Fundus photo
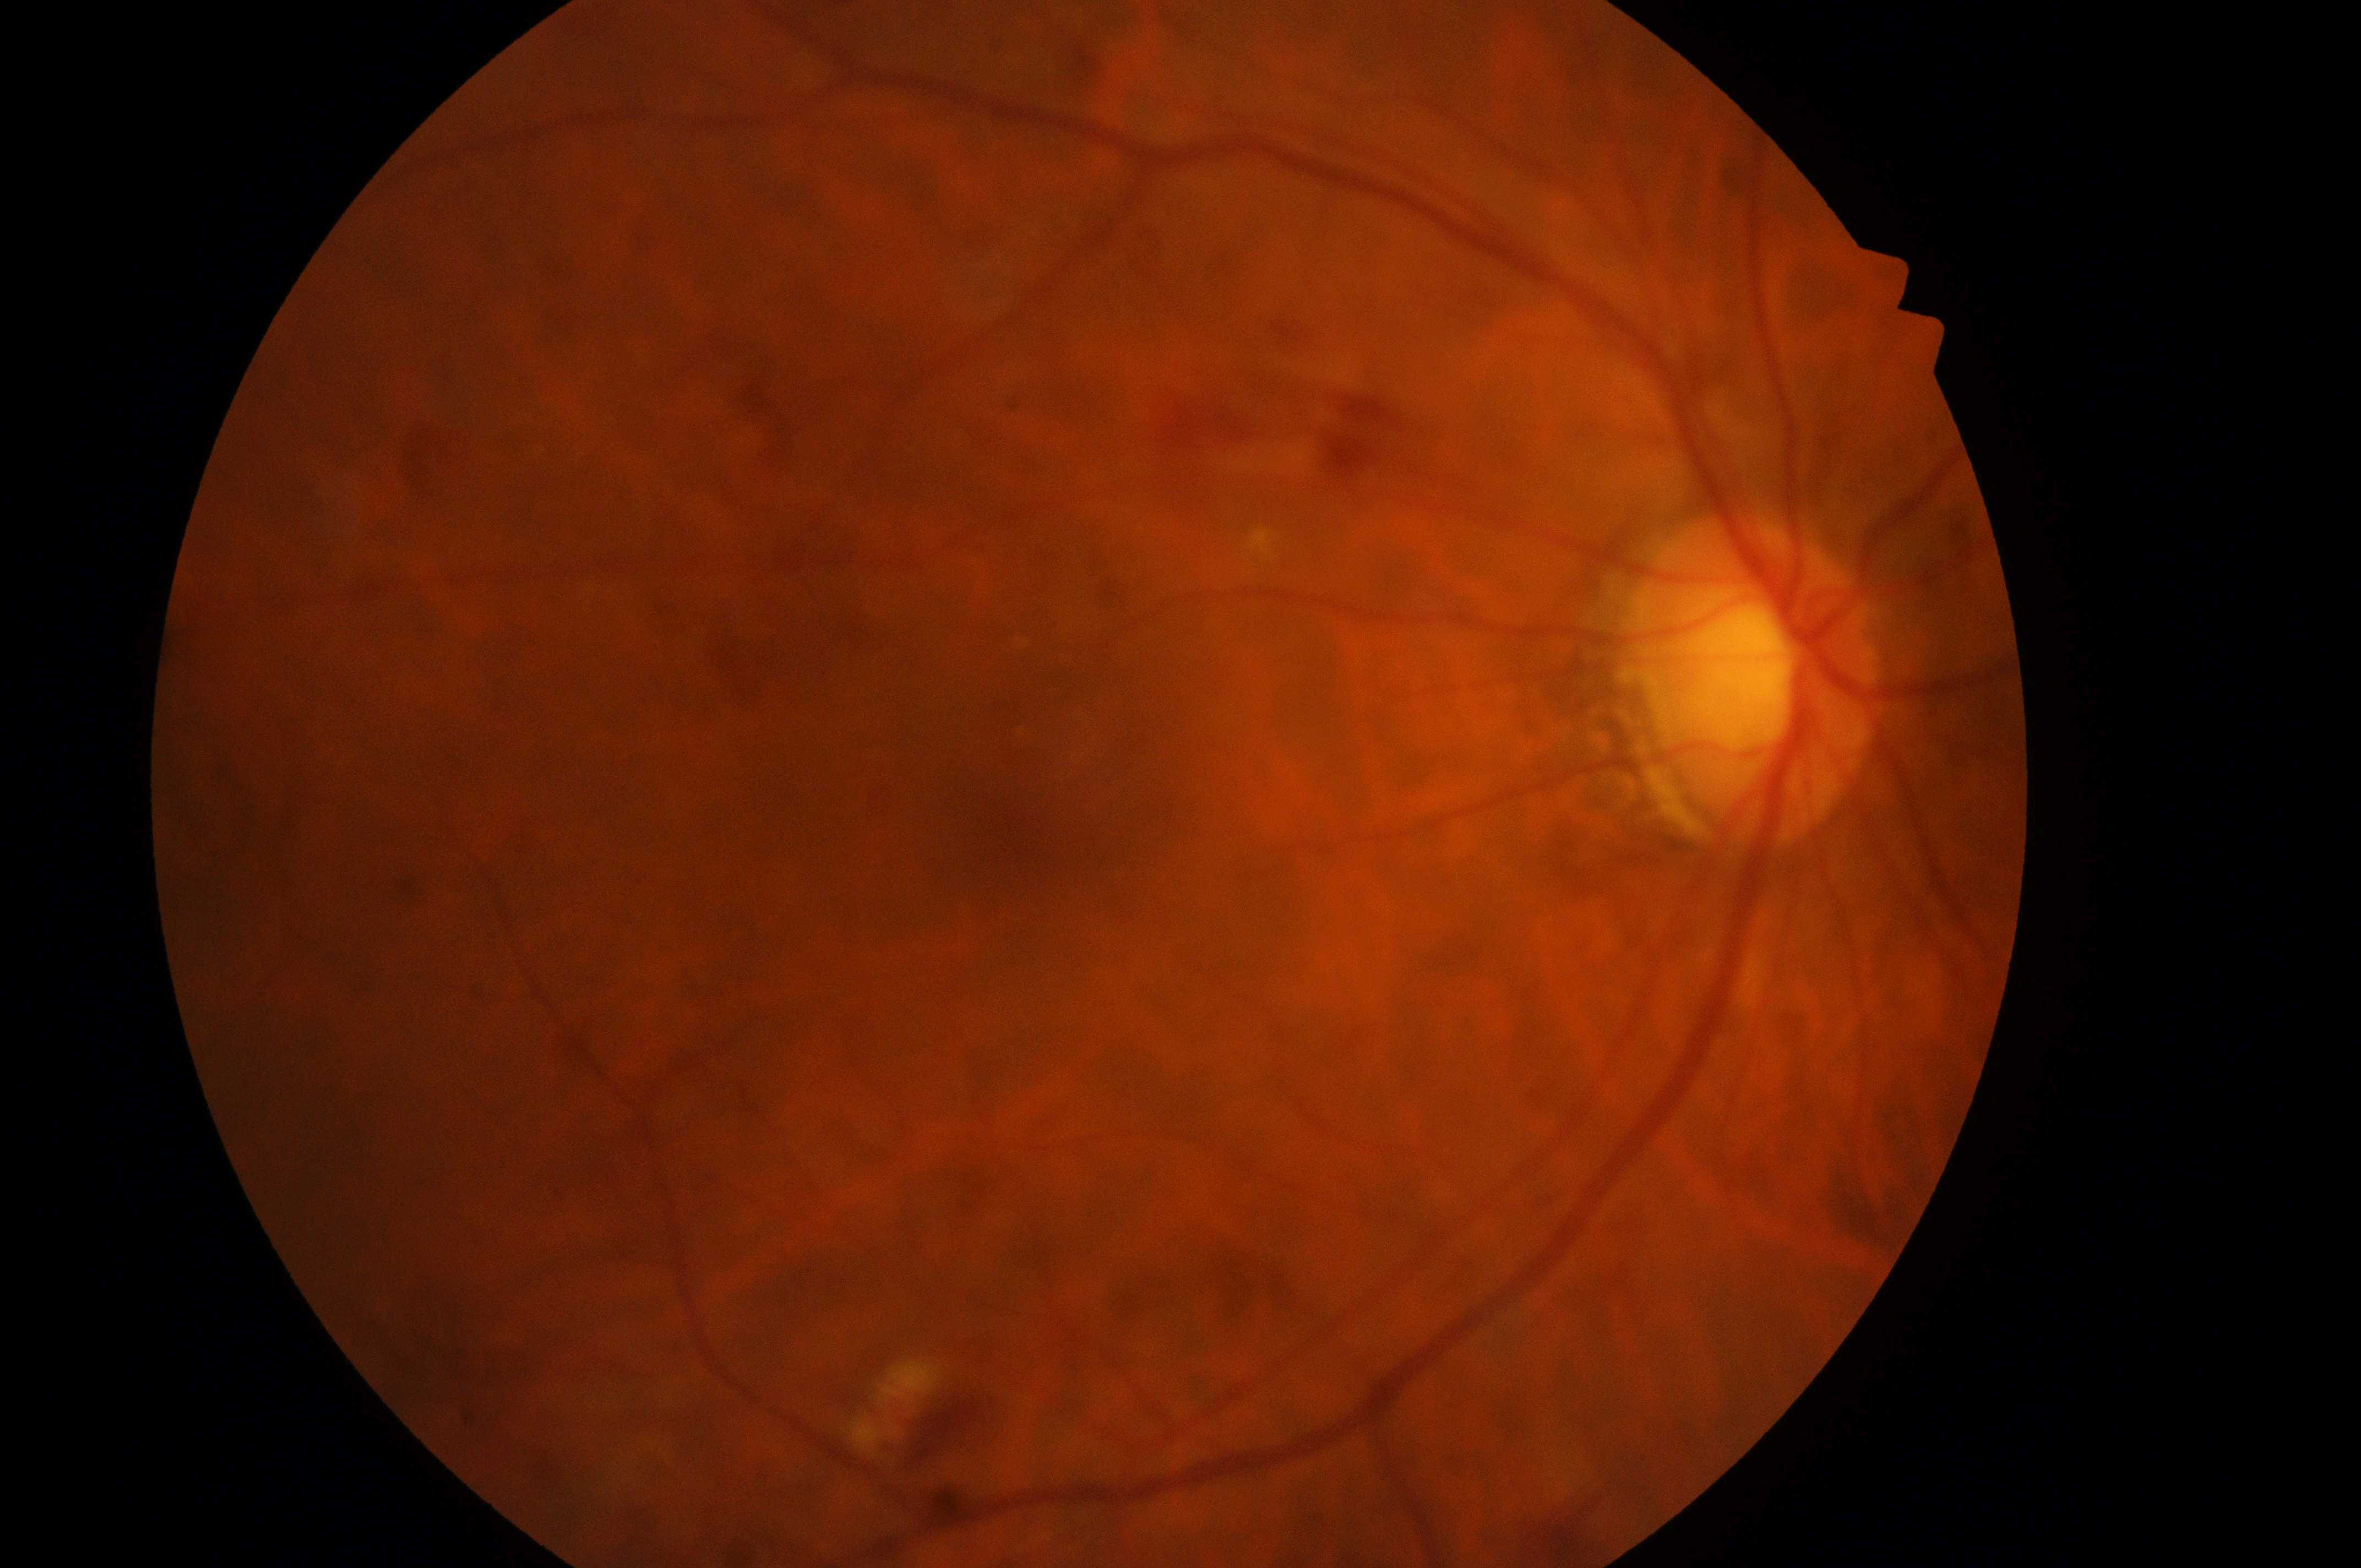 {
  "optic_disc": "1758, 687",
  "dr_grade": "3",
  "eye": "right eye",
  "dme_grade": "2",
  "fovea": "1002, 837"
}